Color fundus photograph; 1725x1721
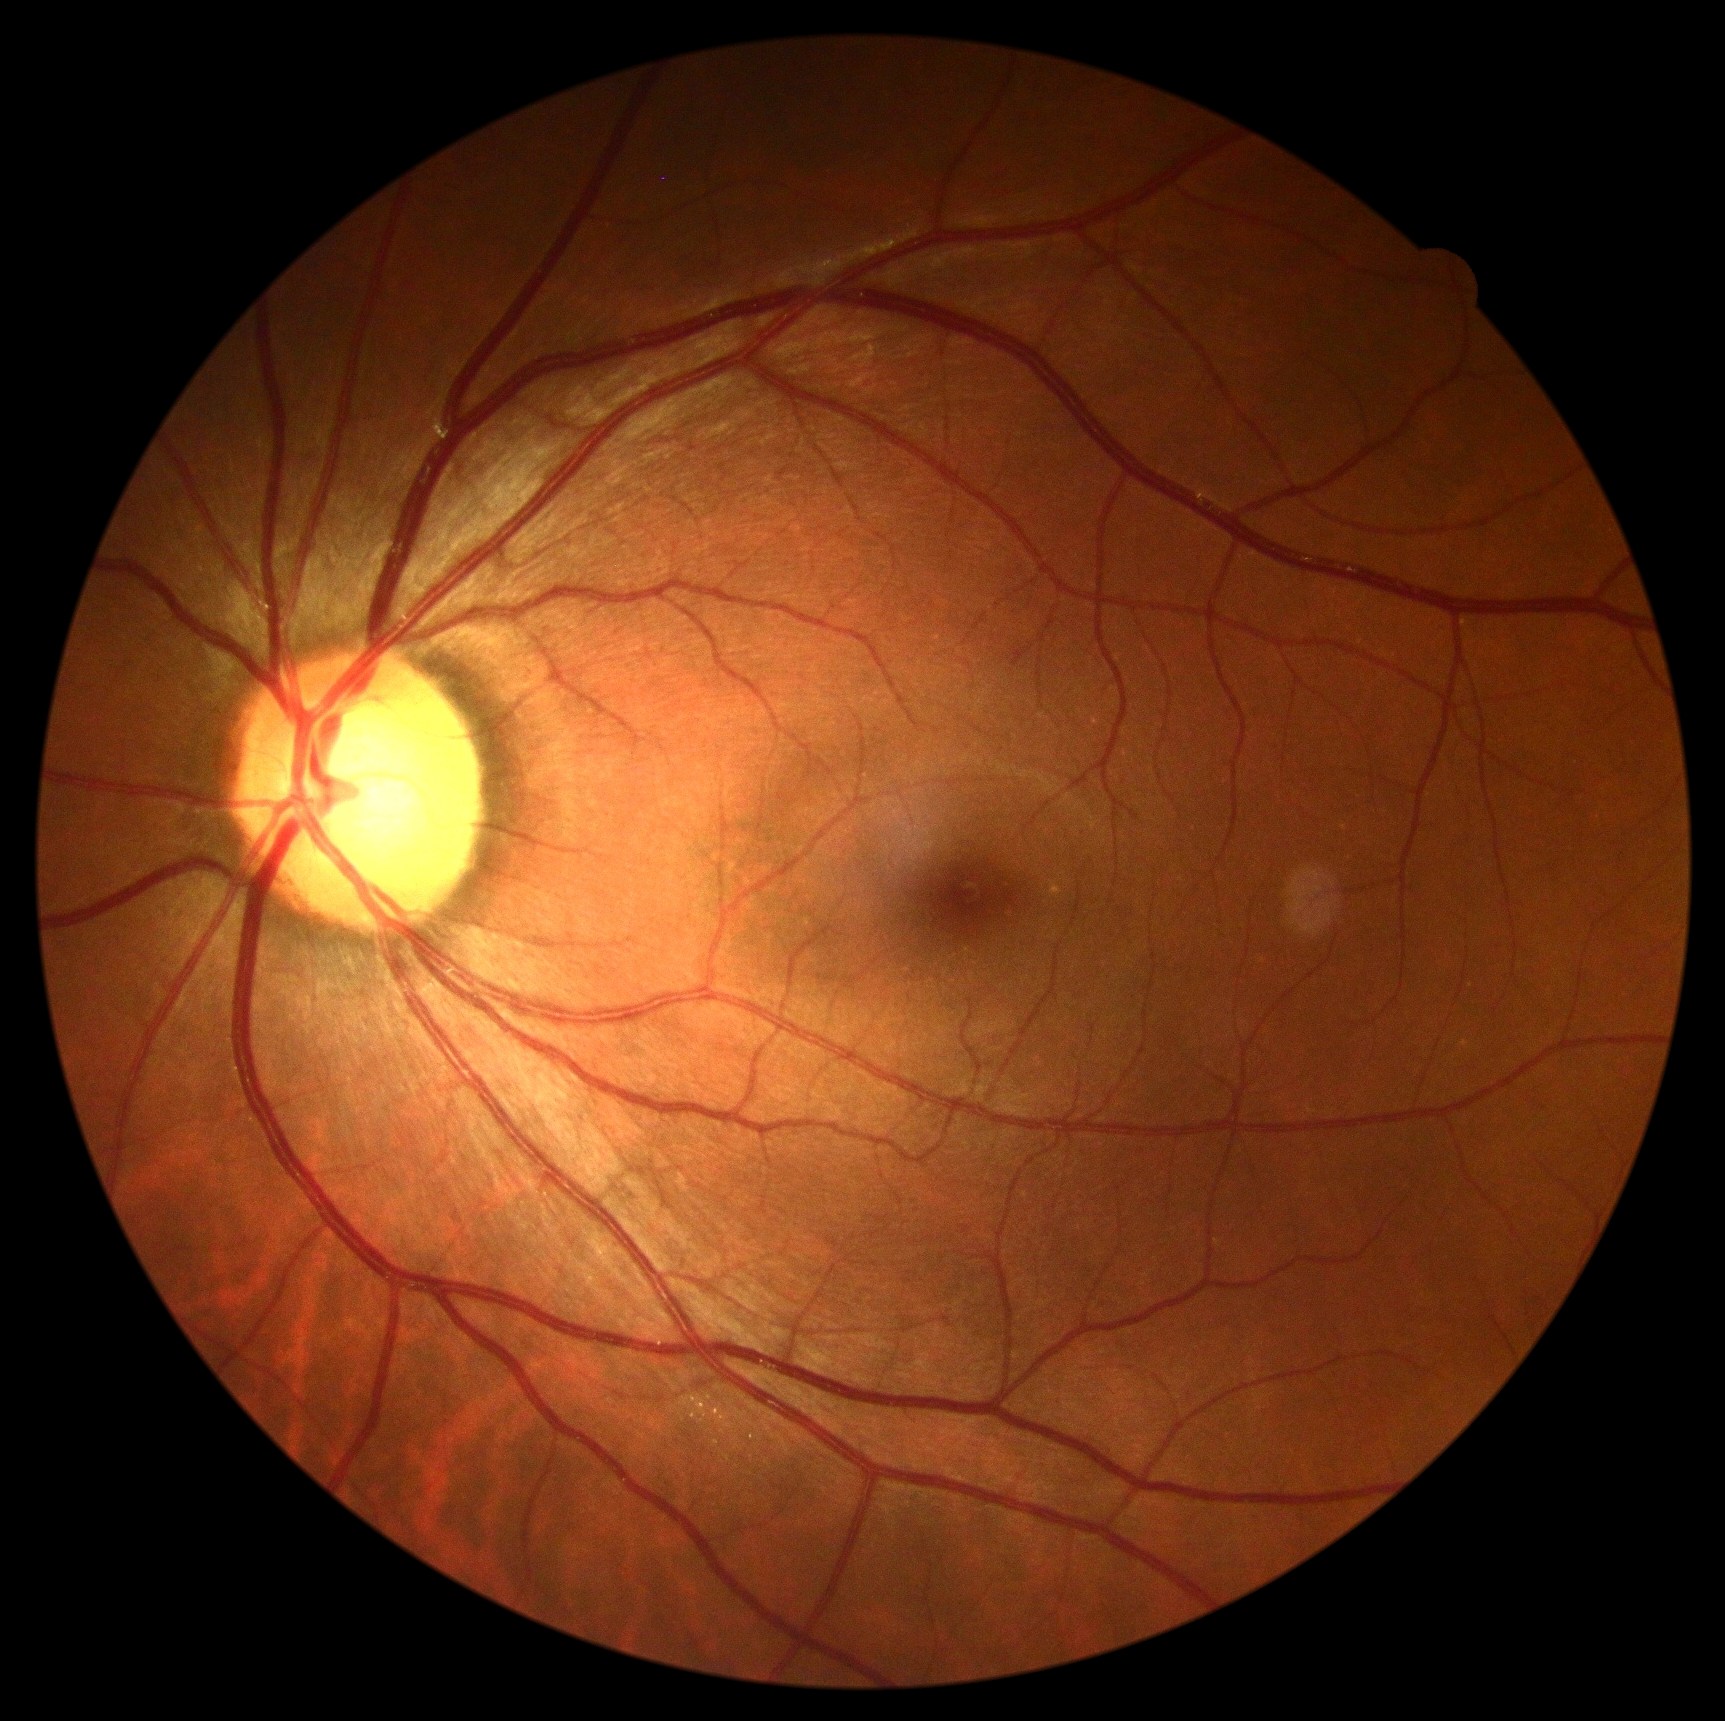 DR severity: no apparent diabetic retinopathy (grade 0) — no visible signs of diabetic retinopathy.